848 x 848 pixels, modified Davis grading:
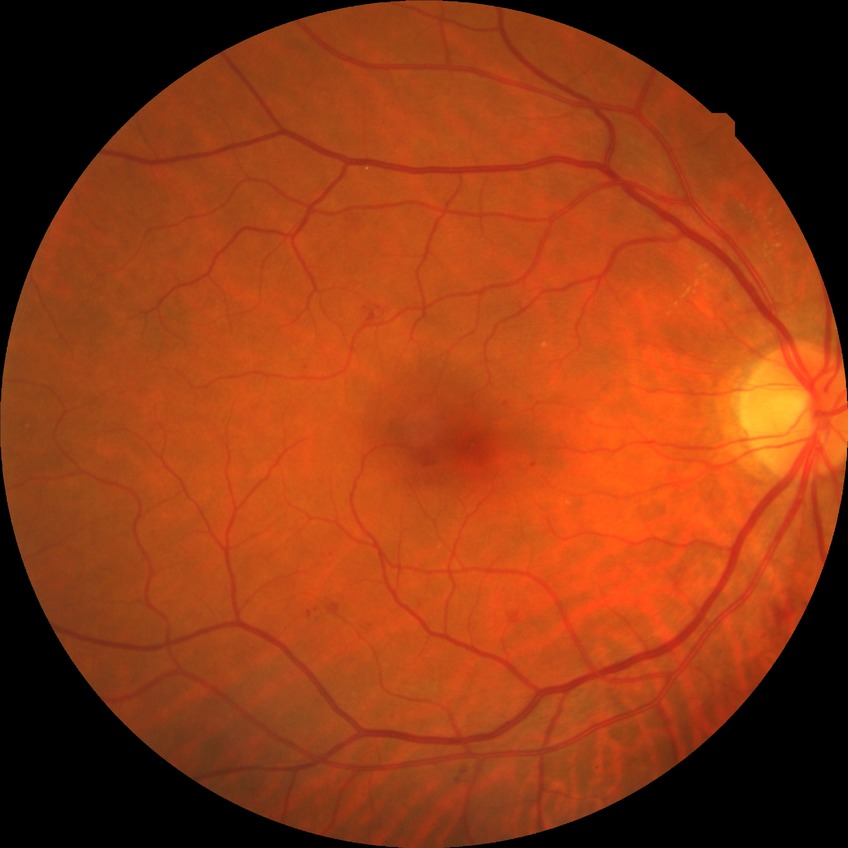 Modified Davis grade: SDR.